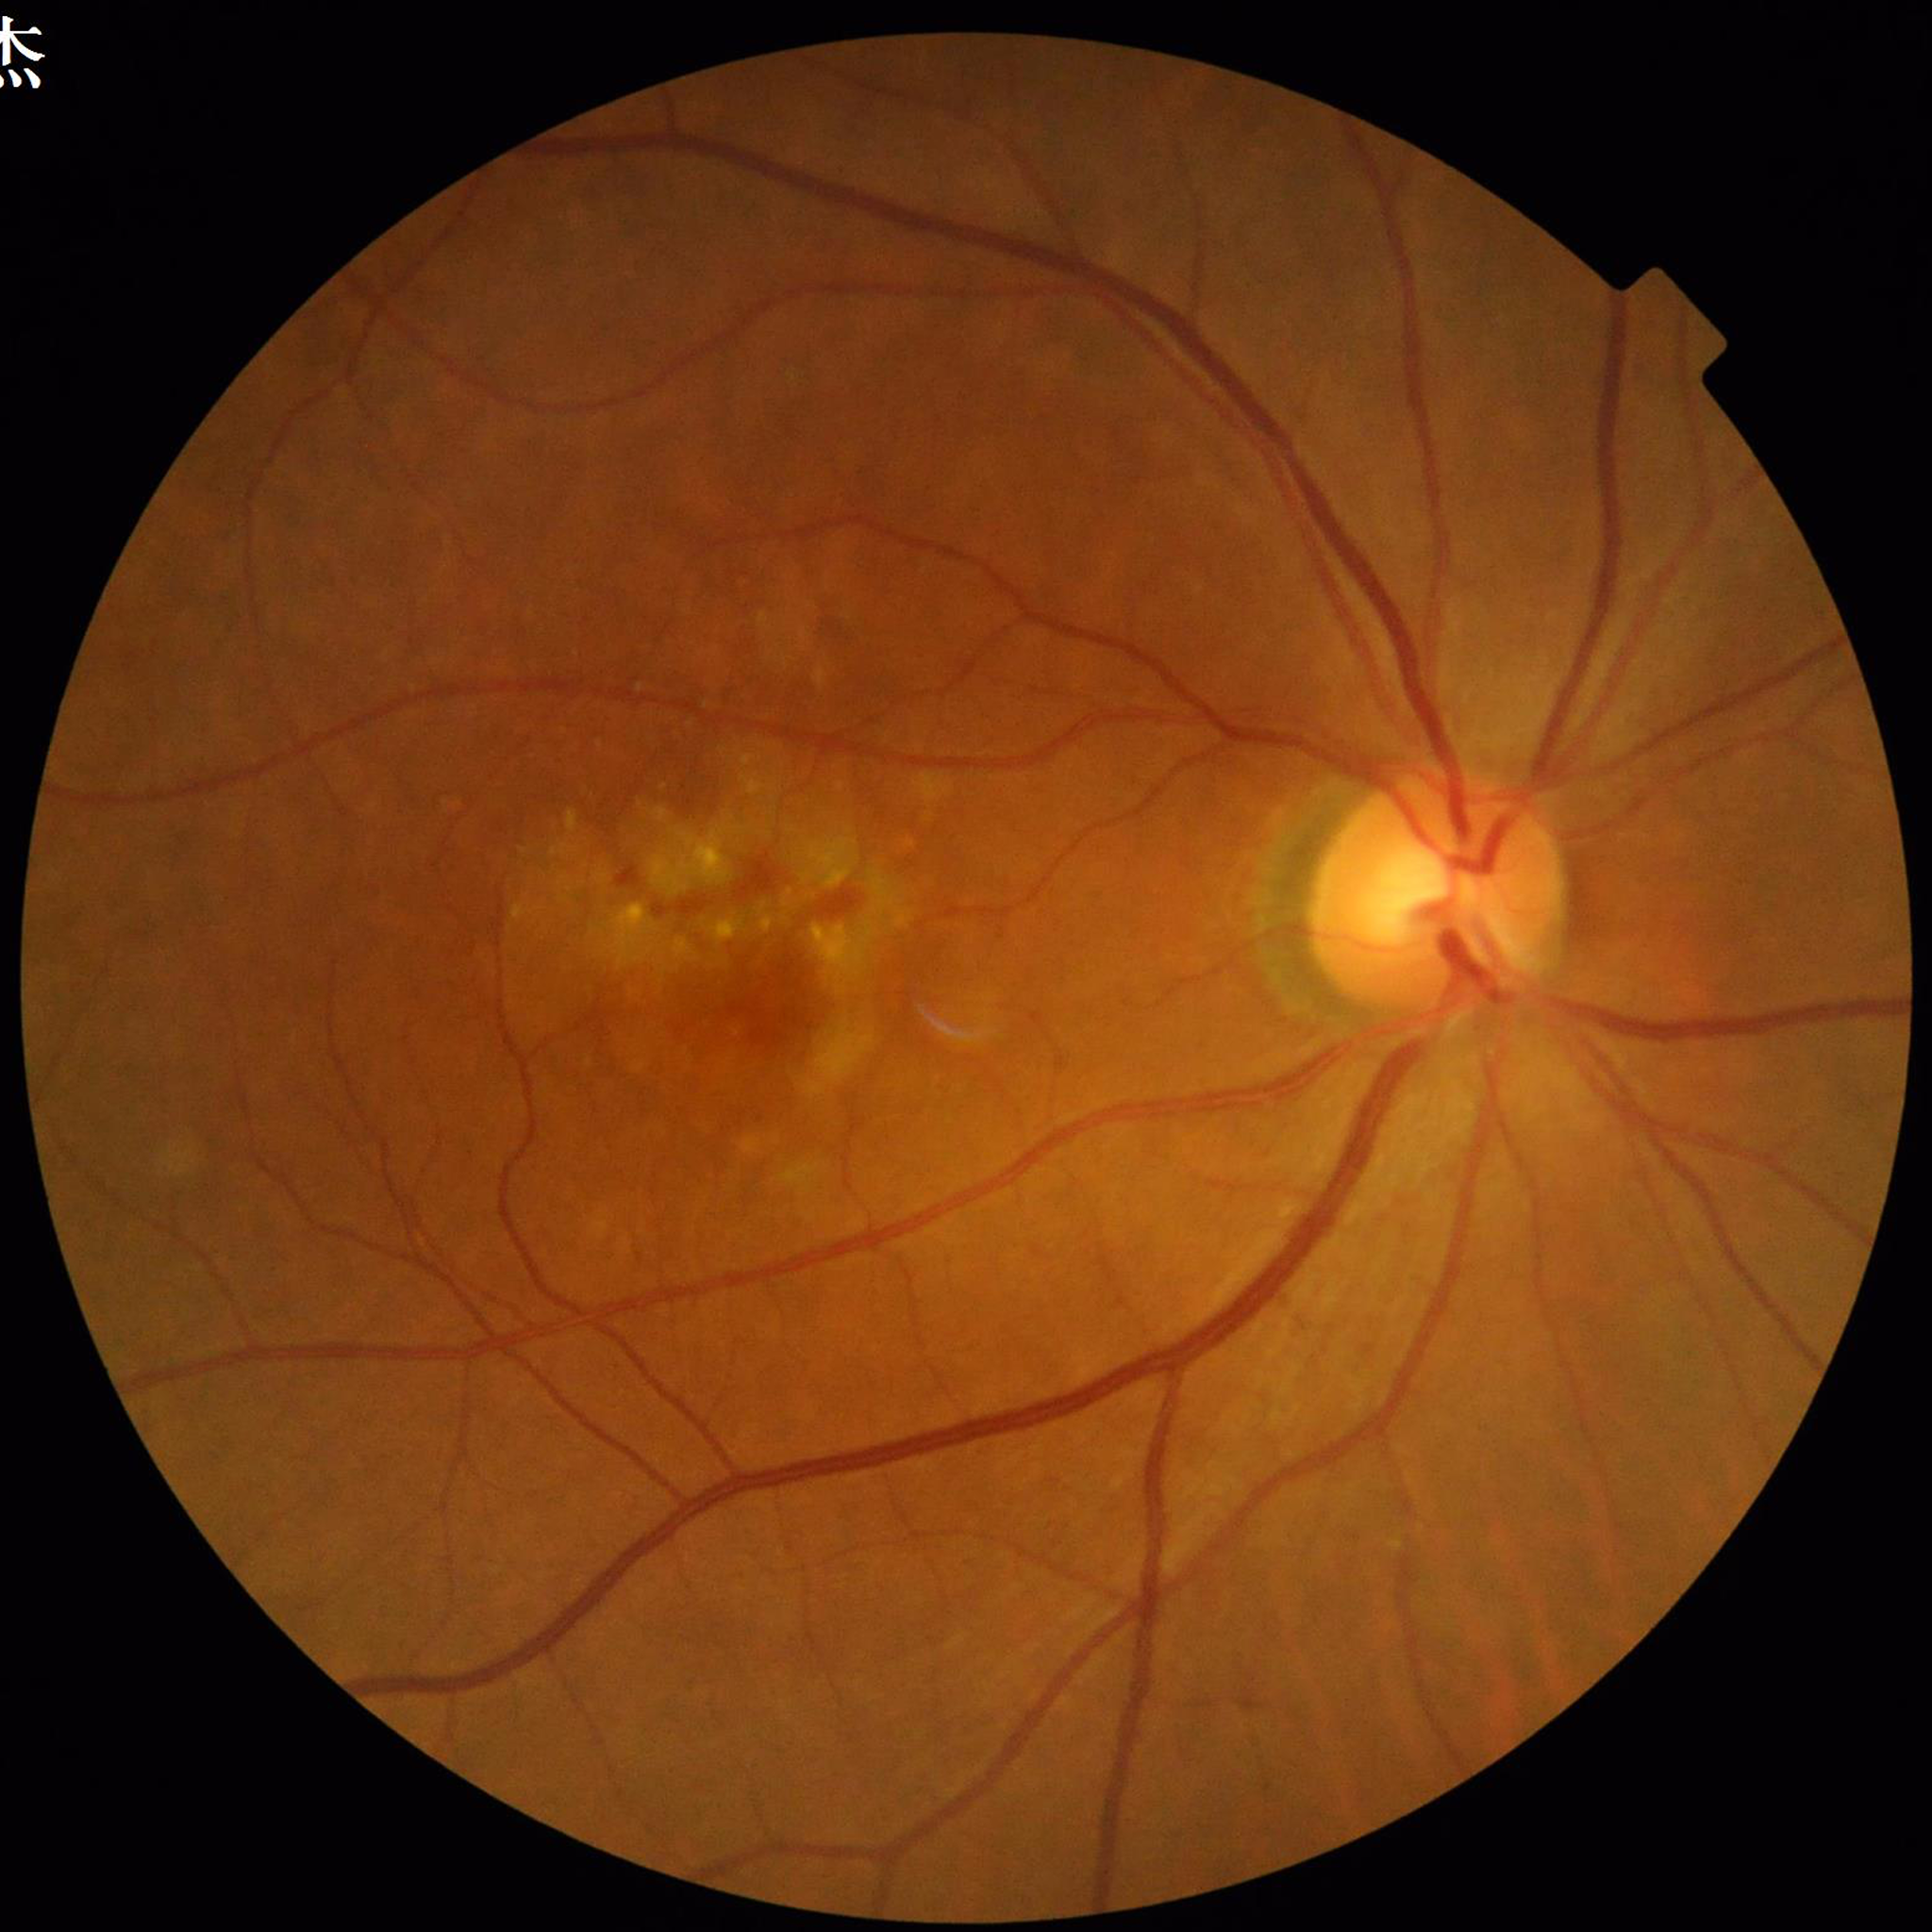 Automated quality assessment: good. From a patient with age-related macular degeneration.